Modified Davis grading:
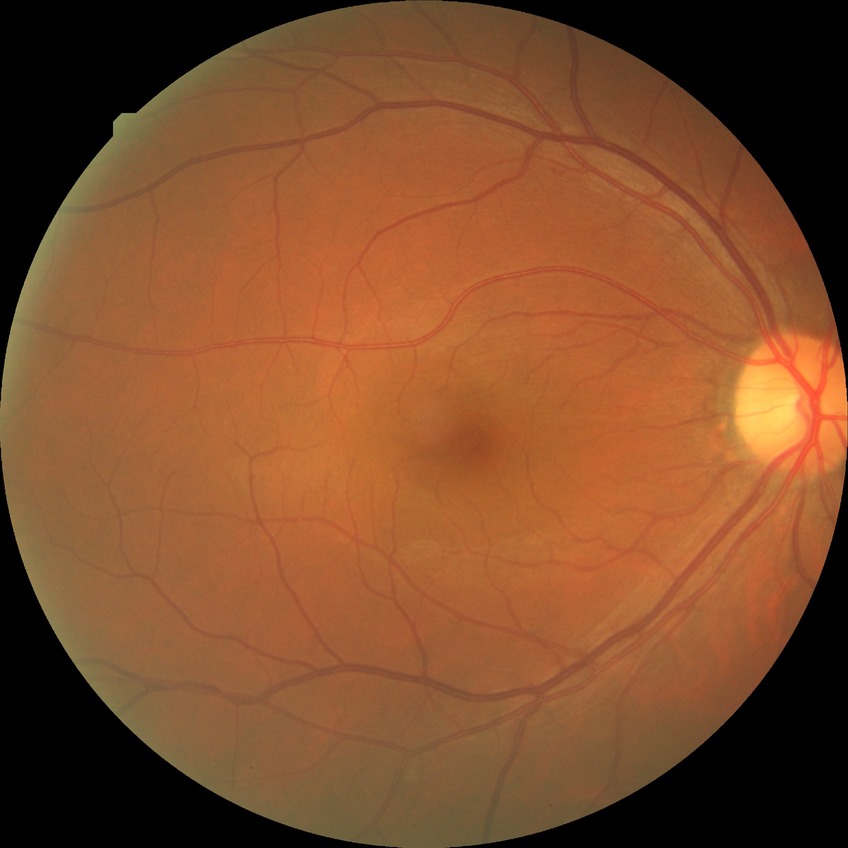
diabetic retinopathy (DR)@SDR (simple diabetic retinopathy).